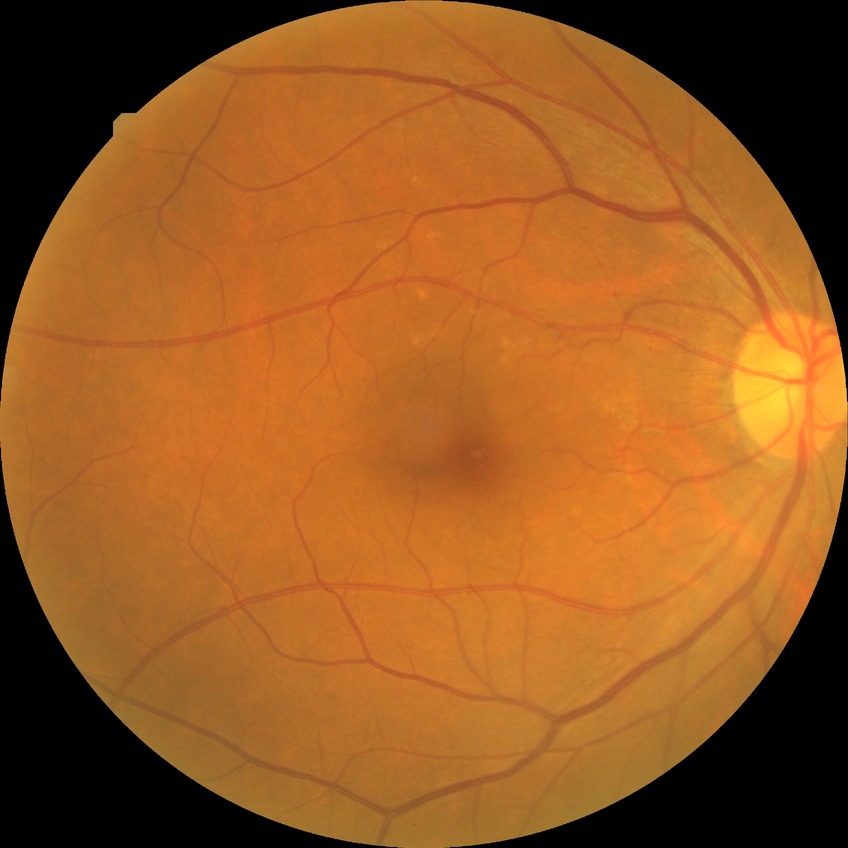
diabetic retinopathy grade=no diabetic retinopathy.